1659x2212: 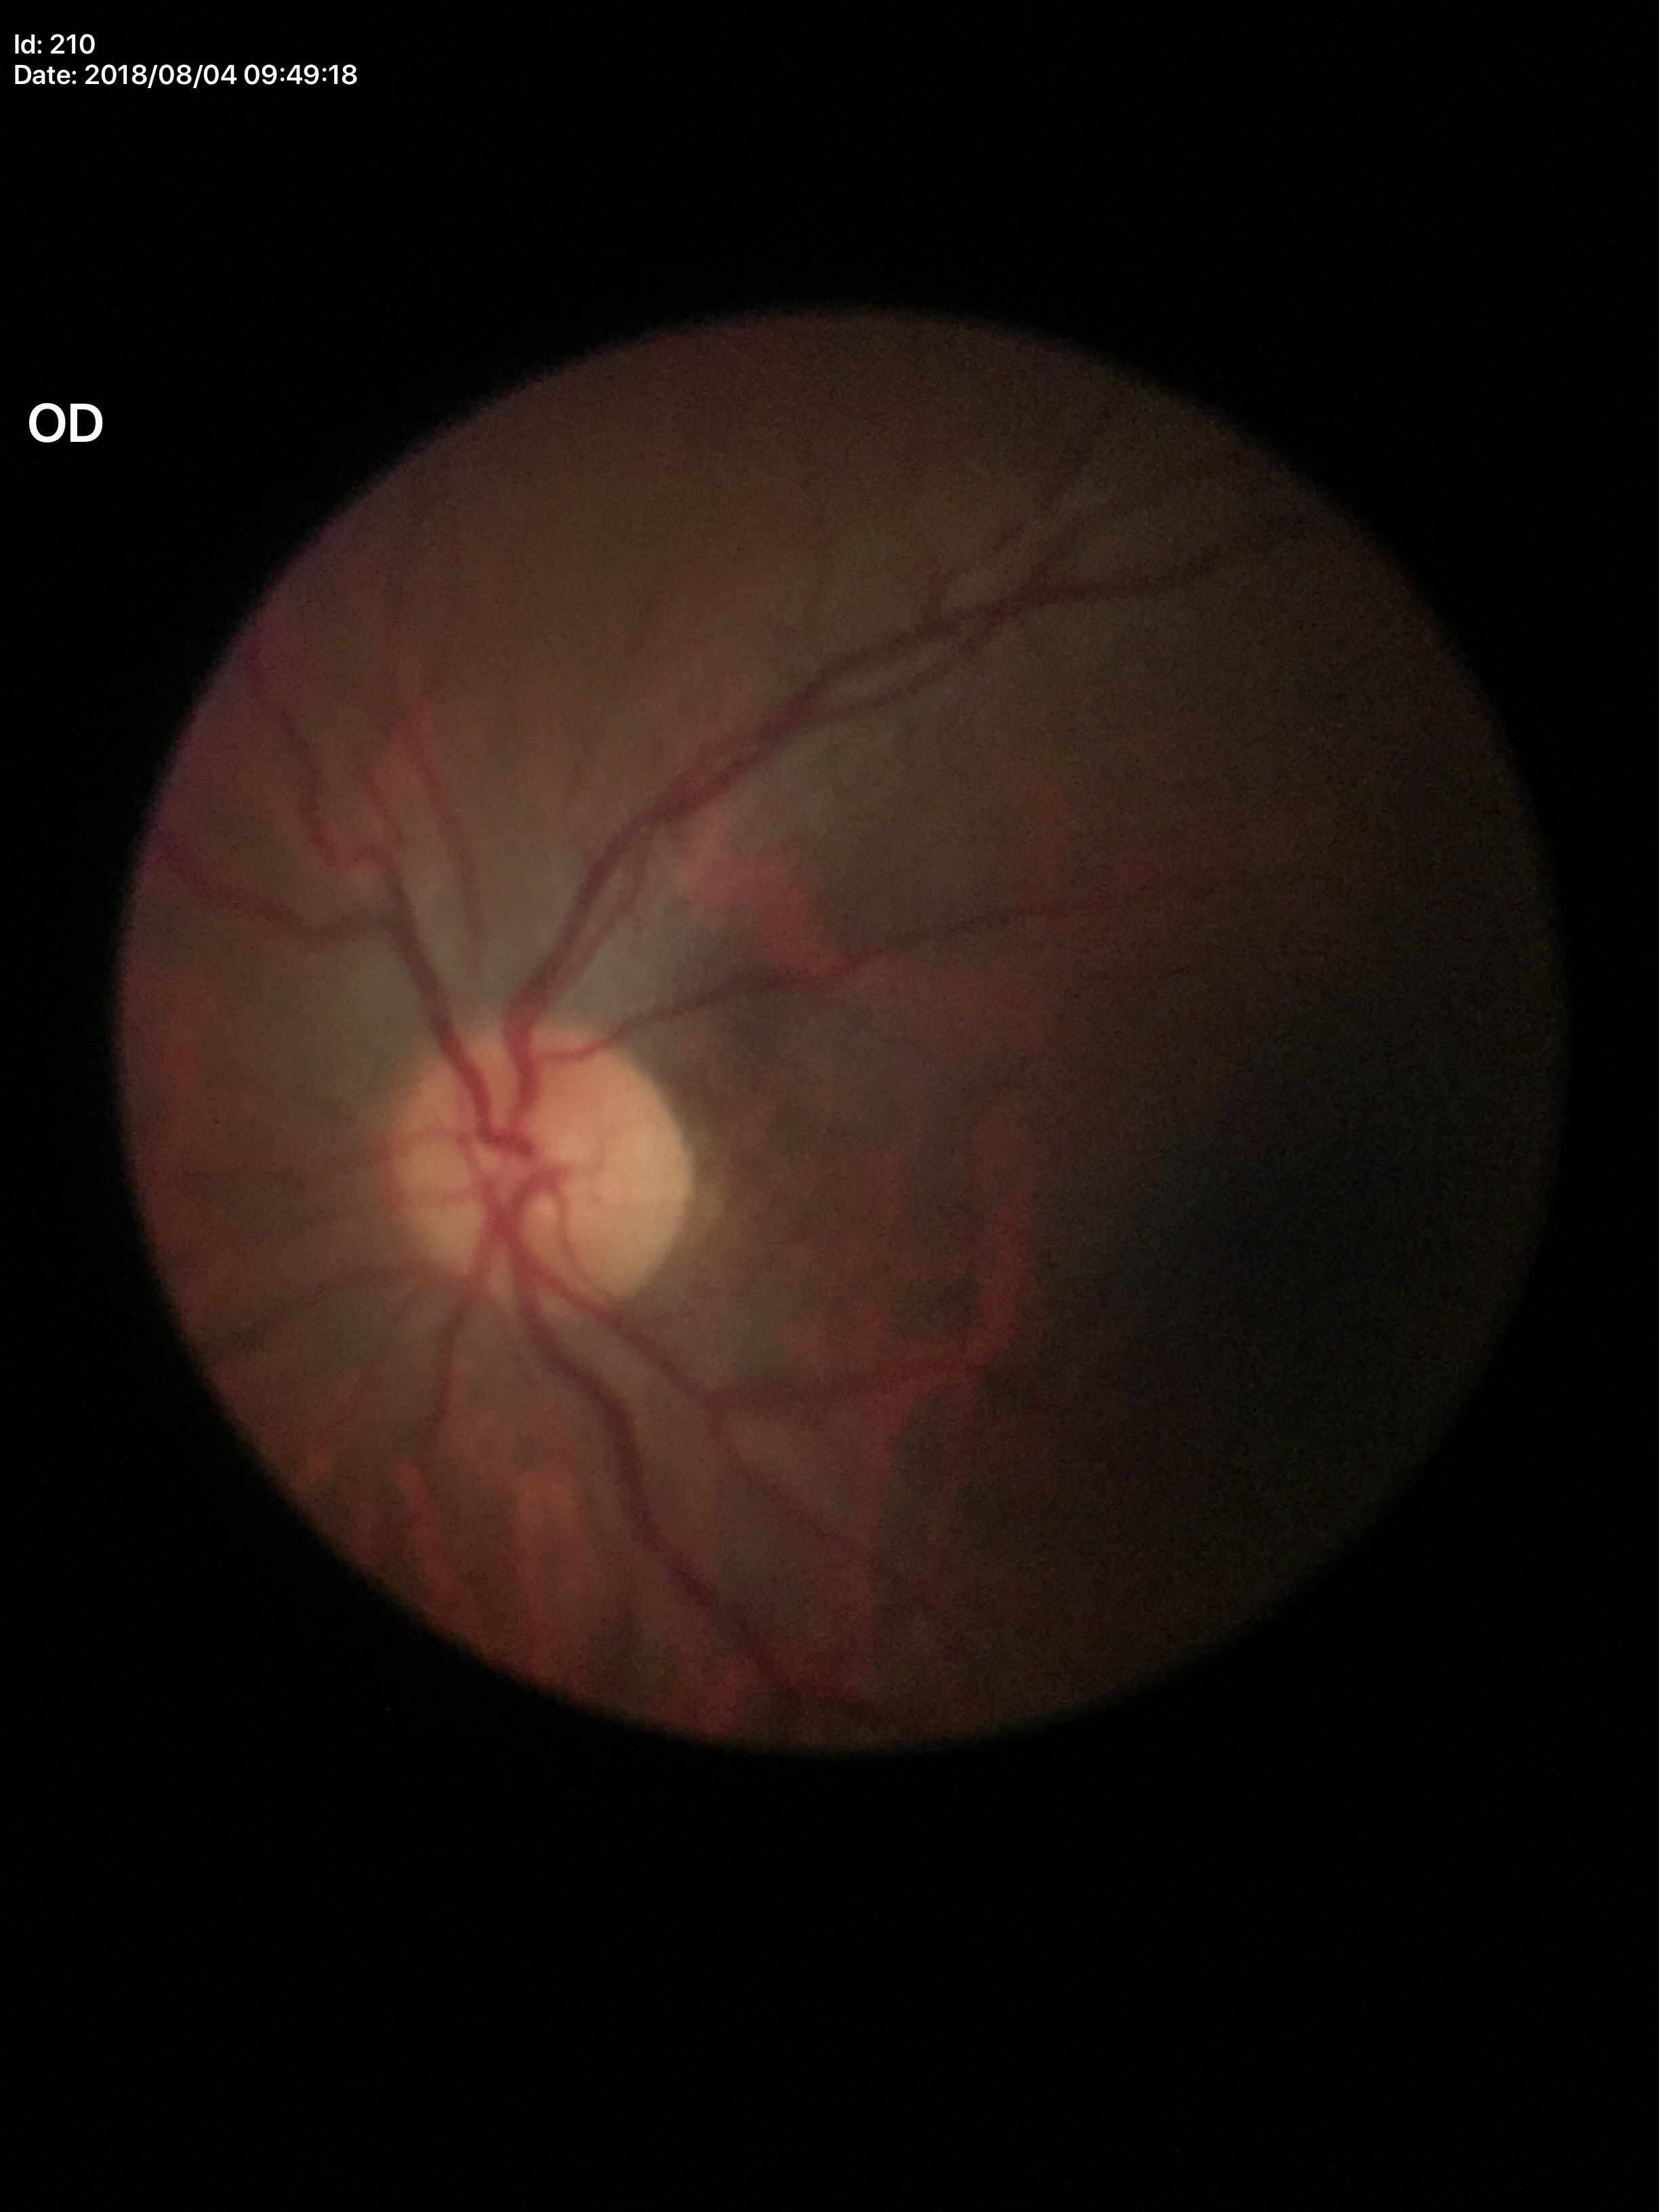

Glaucoma evaluation = not suspect
VCDR = 0.53